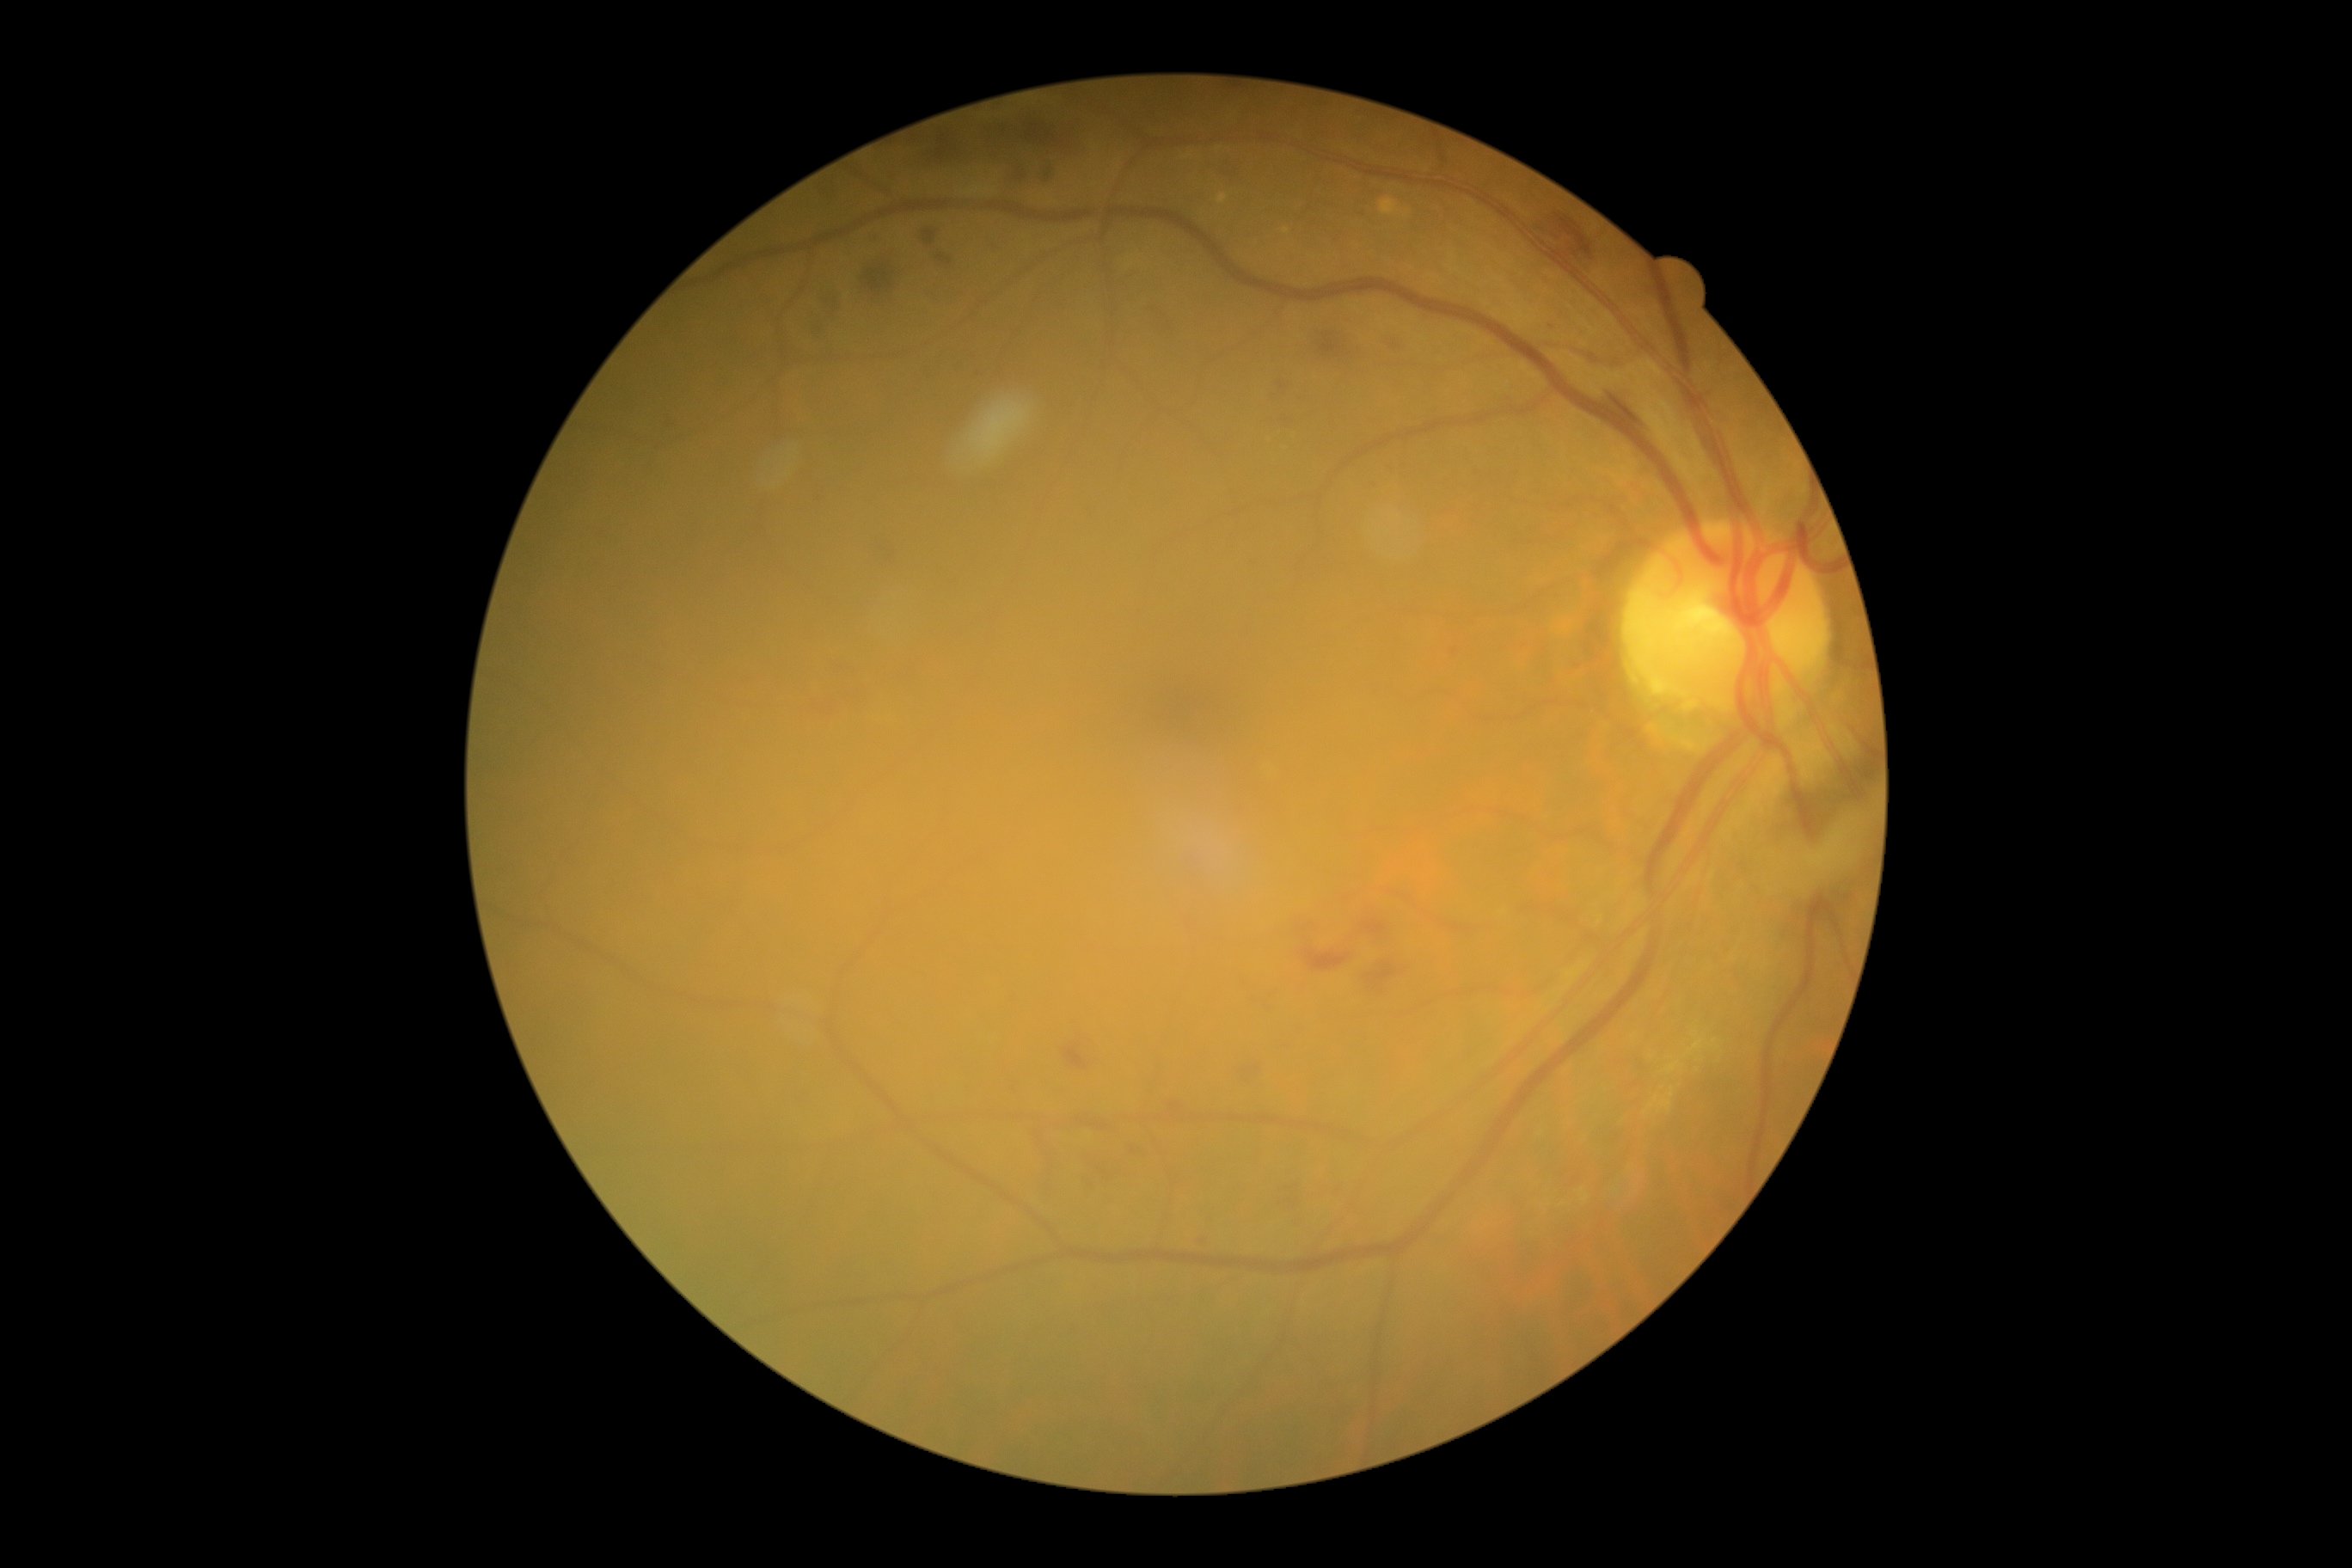

partial: true
dr_grade: 2
dr_grade_name: moderate NPDR
lesions:
  he:
    - BBox(836, 659, 861, 682)
    - BBox(921, 228, 957, 271)
    - BBox(859, 255, 907, 307)
    - BBox(926, 369, 933, 379)
    - BBox(871, 539, 902, 570)
    - BBox(1234, 1055, 1263, 1086)
    - BBox(1012, 166, 1029, 185)
    - BBox(812, 315, 830, 336)
    - BBox(1268, 989, 1280, 1000)
    - BBox(1447, 635, 1464, 661)
    - BBox(981, 114, 1082, 159)
    - BBox(1359, 959, 1411, 996)
    - BBox(1330, 231, 1345, 245)
  he_small_centers:
    - Point(1391, 470)